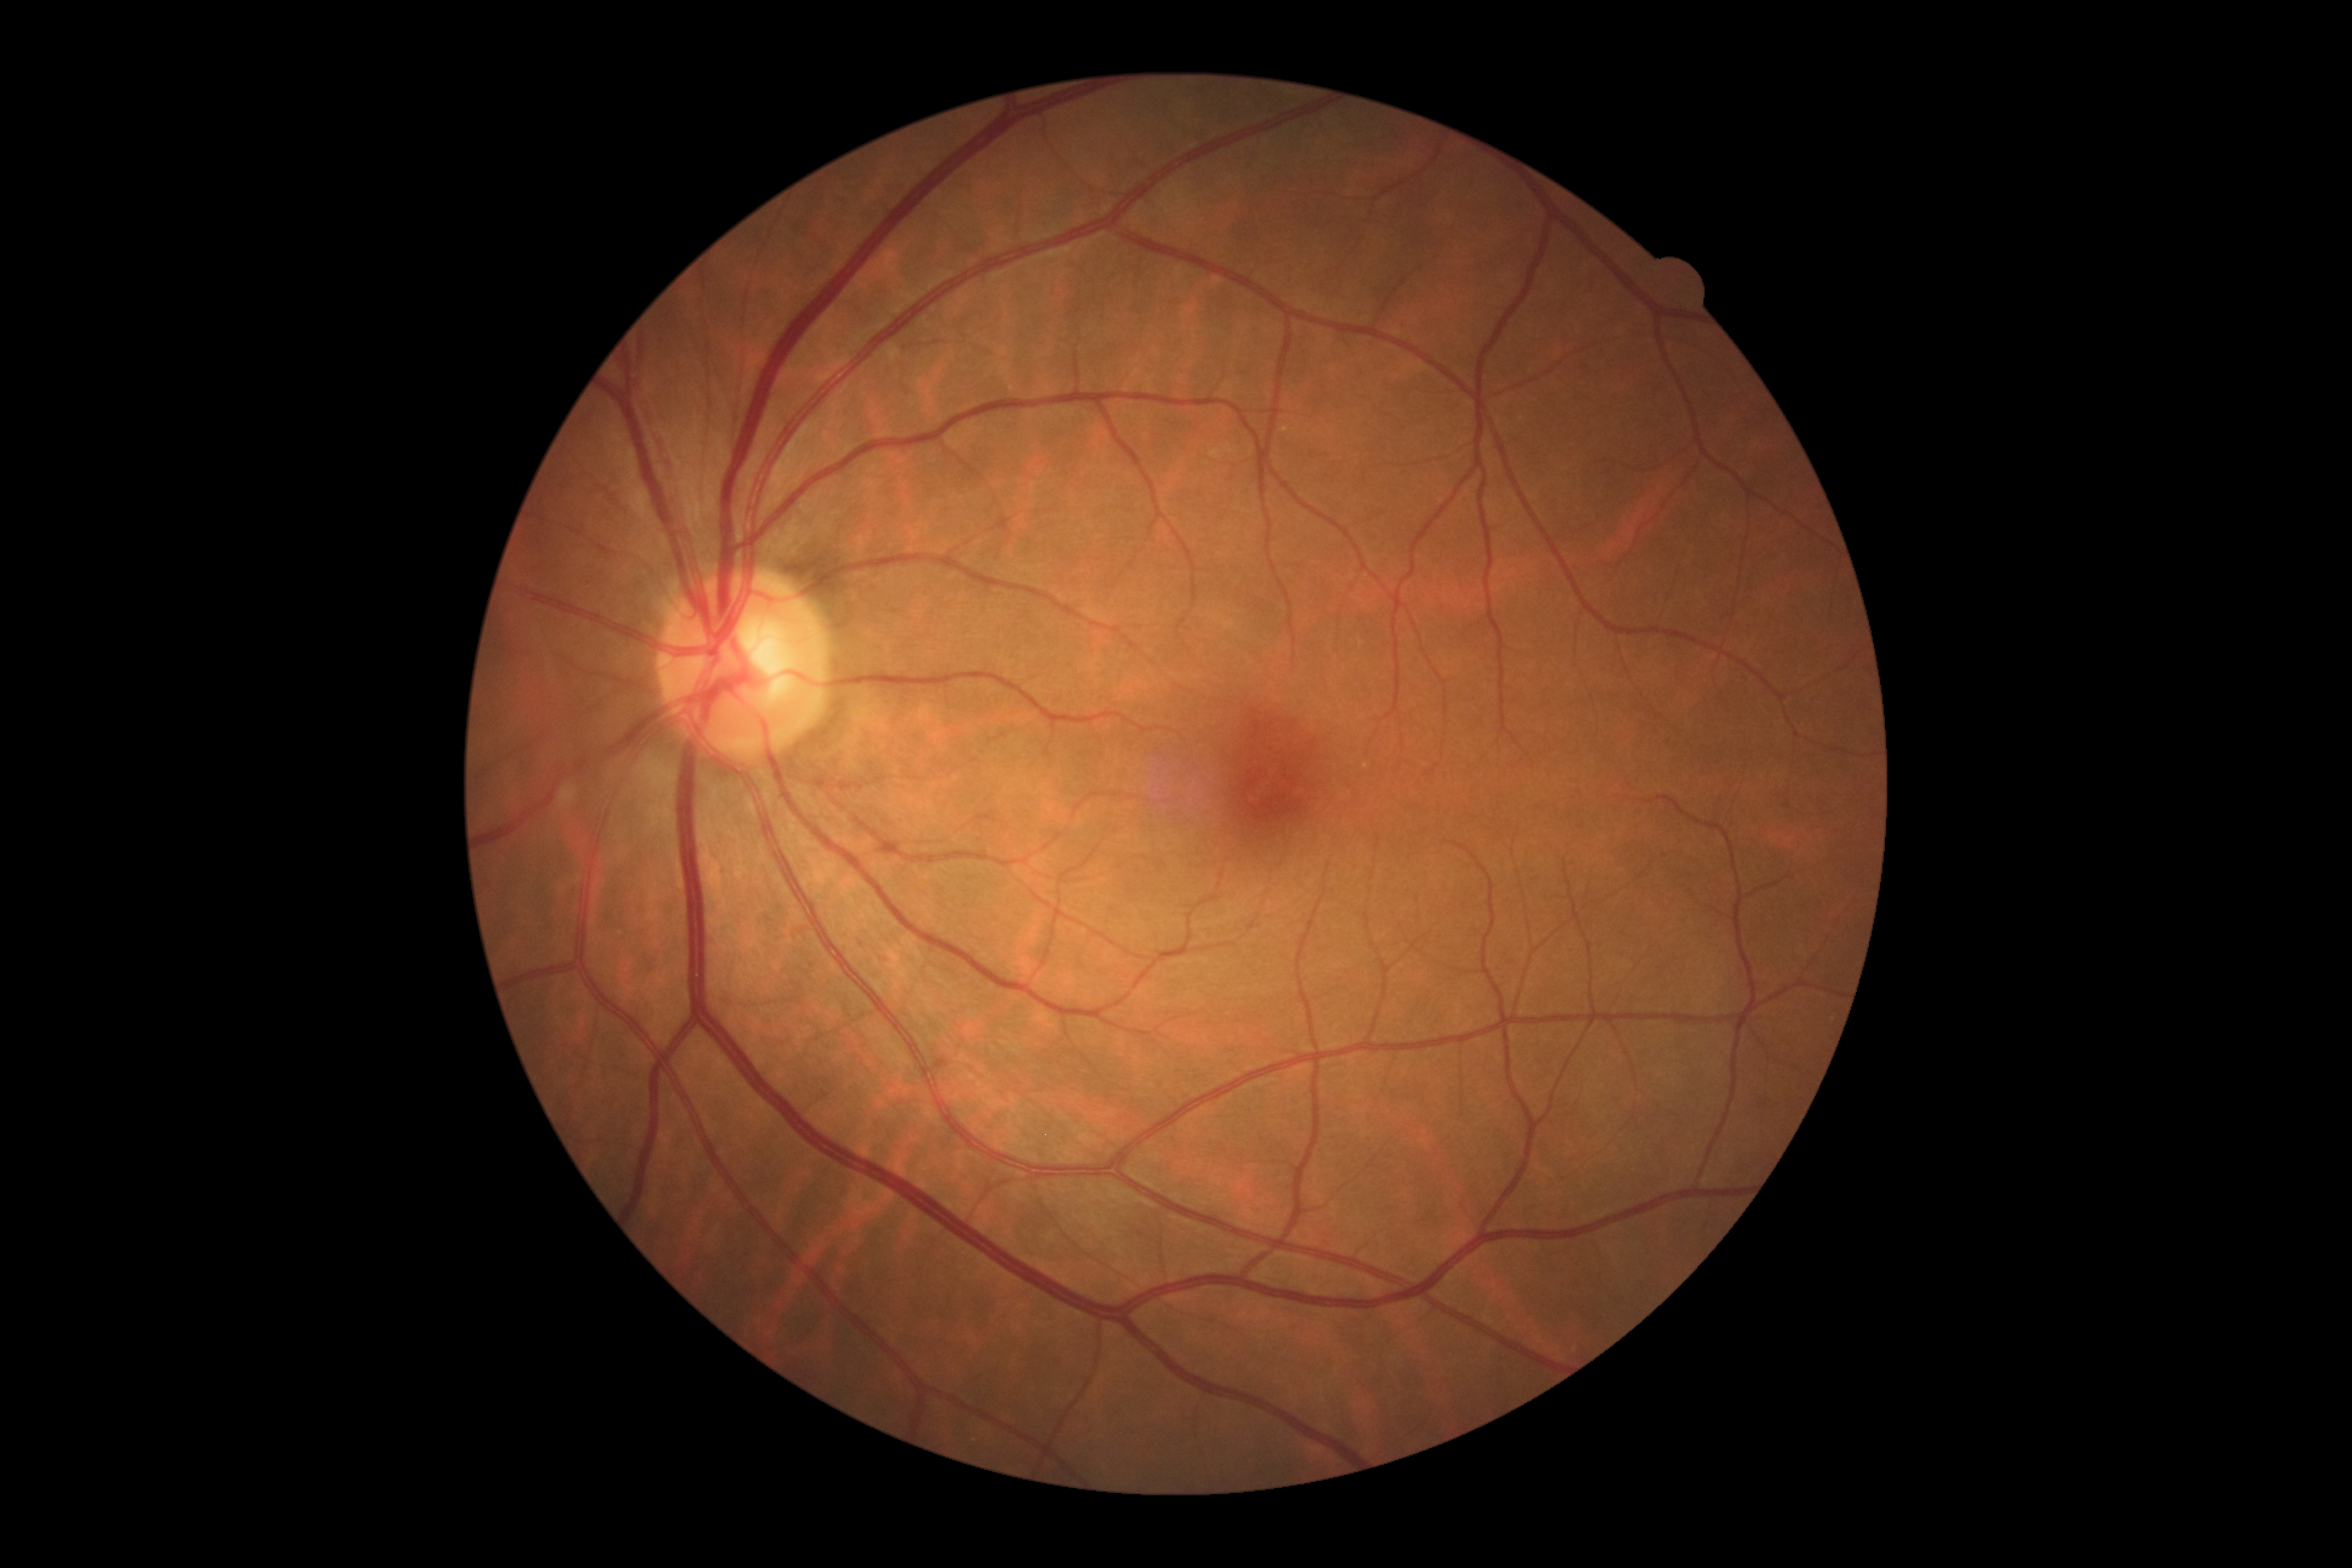

diabetic retinopathy (DR)@0, DR impression@no apparent DR.